848 by 848 pixels · no pharmacologic dilation · diabetic retinopathy graded by the modified Davis classification:
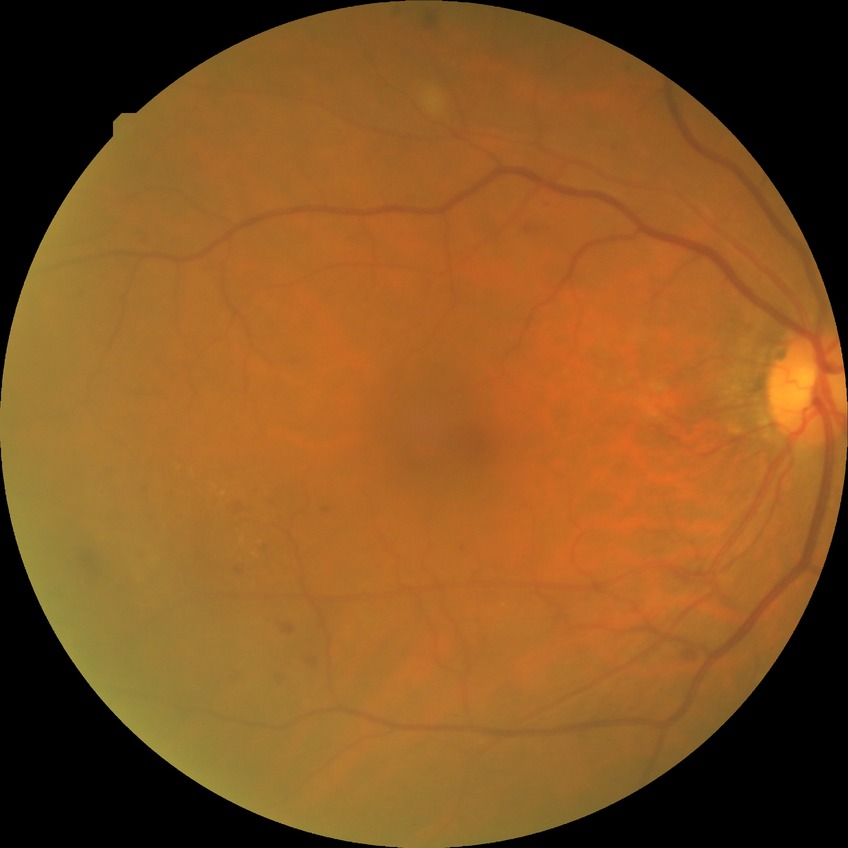
Diabetic retinopathy (DR): SDR (simple diabetic retinopathy).